Image size 2212x1672: 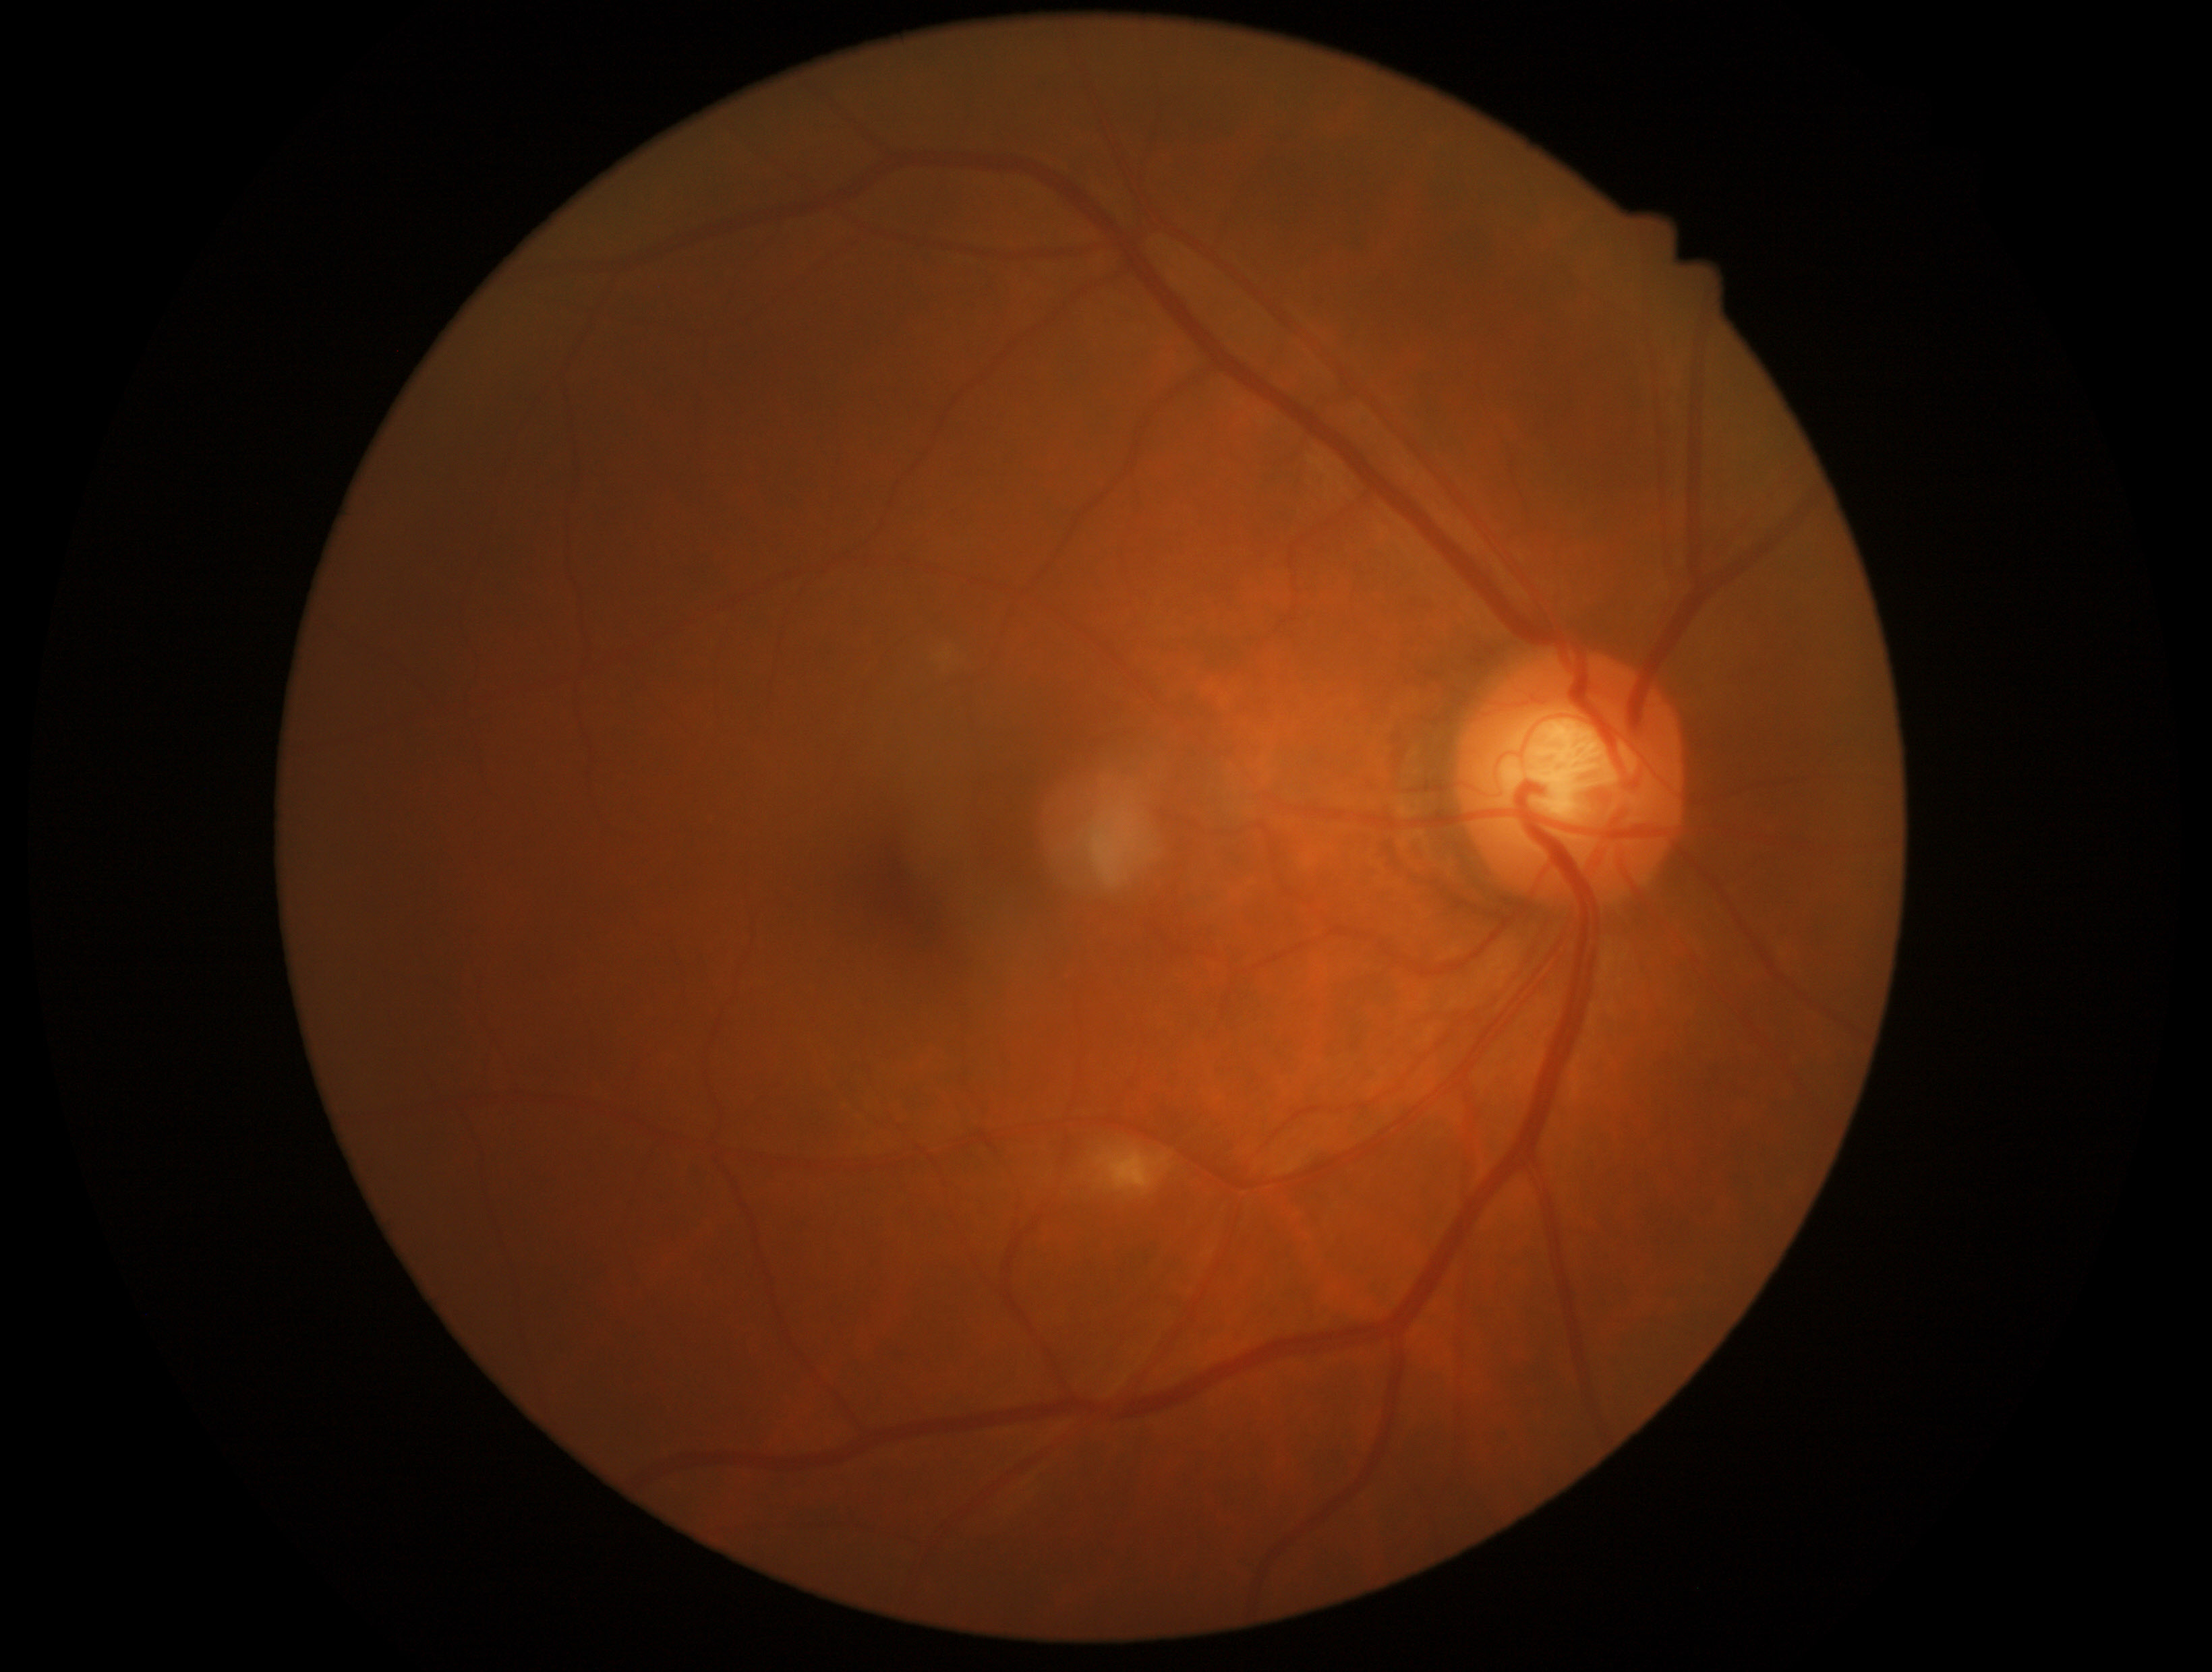

The retinopathy is classified as non-proliferative diabetic retinopathy. Retinopathy: moderate non-proliferative diabetic retinopathy (grade 2).